Color fundus photograph. 45° FOV. 2212 by 1659 pixels.
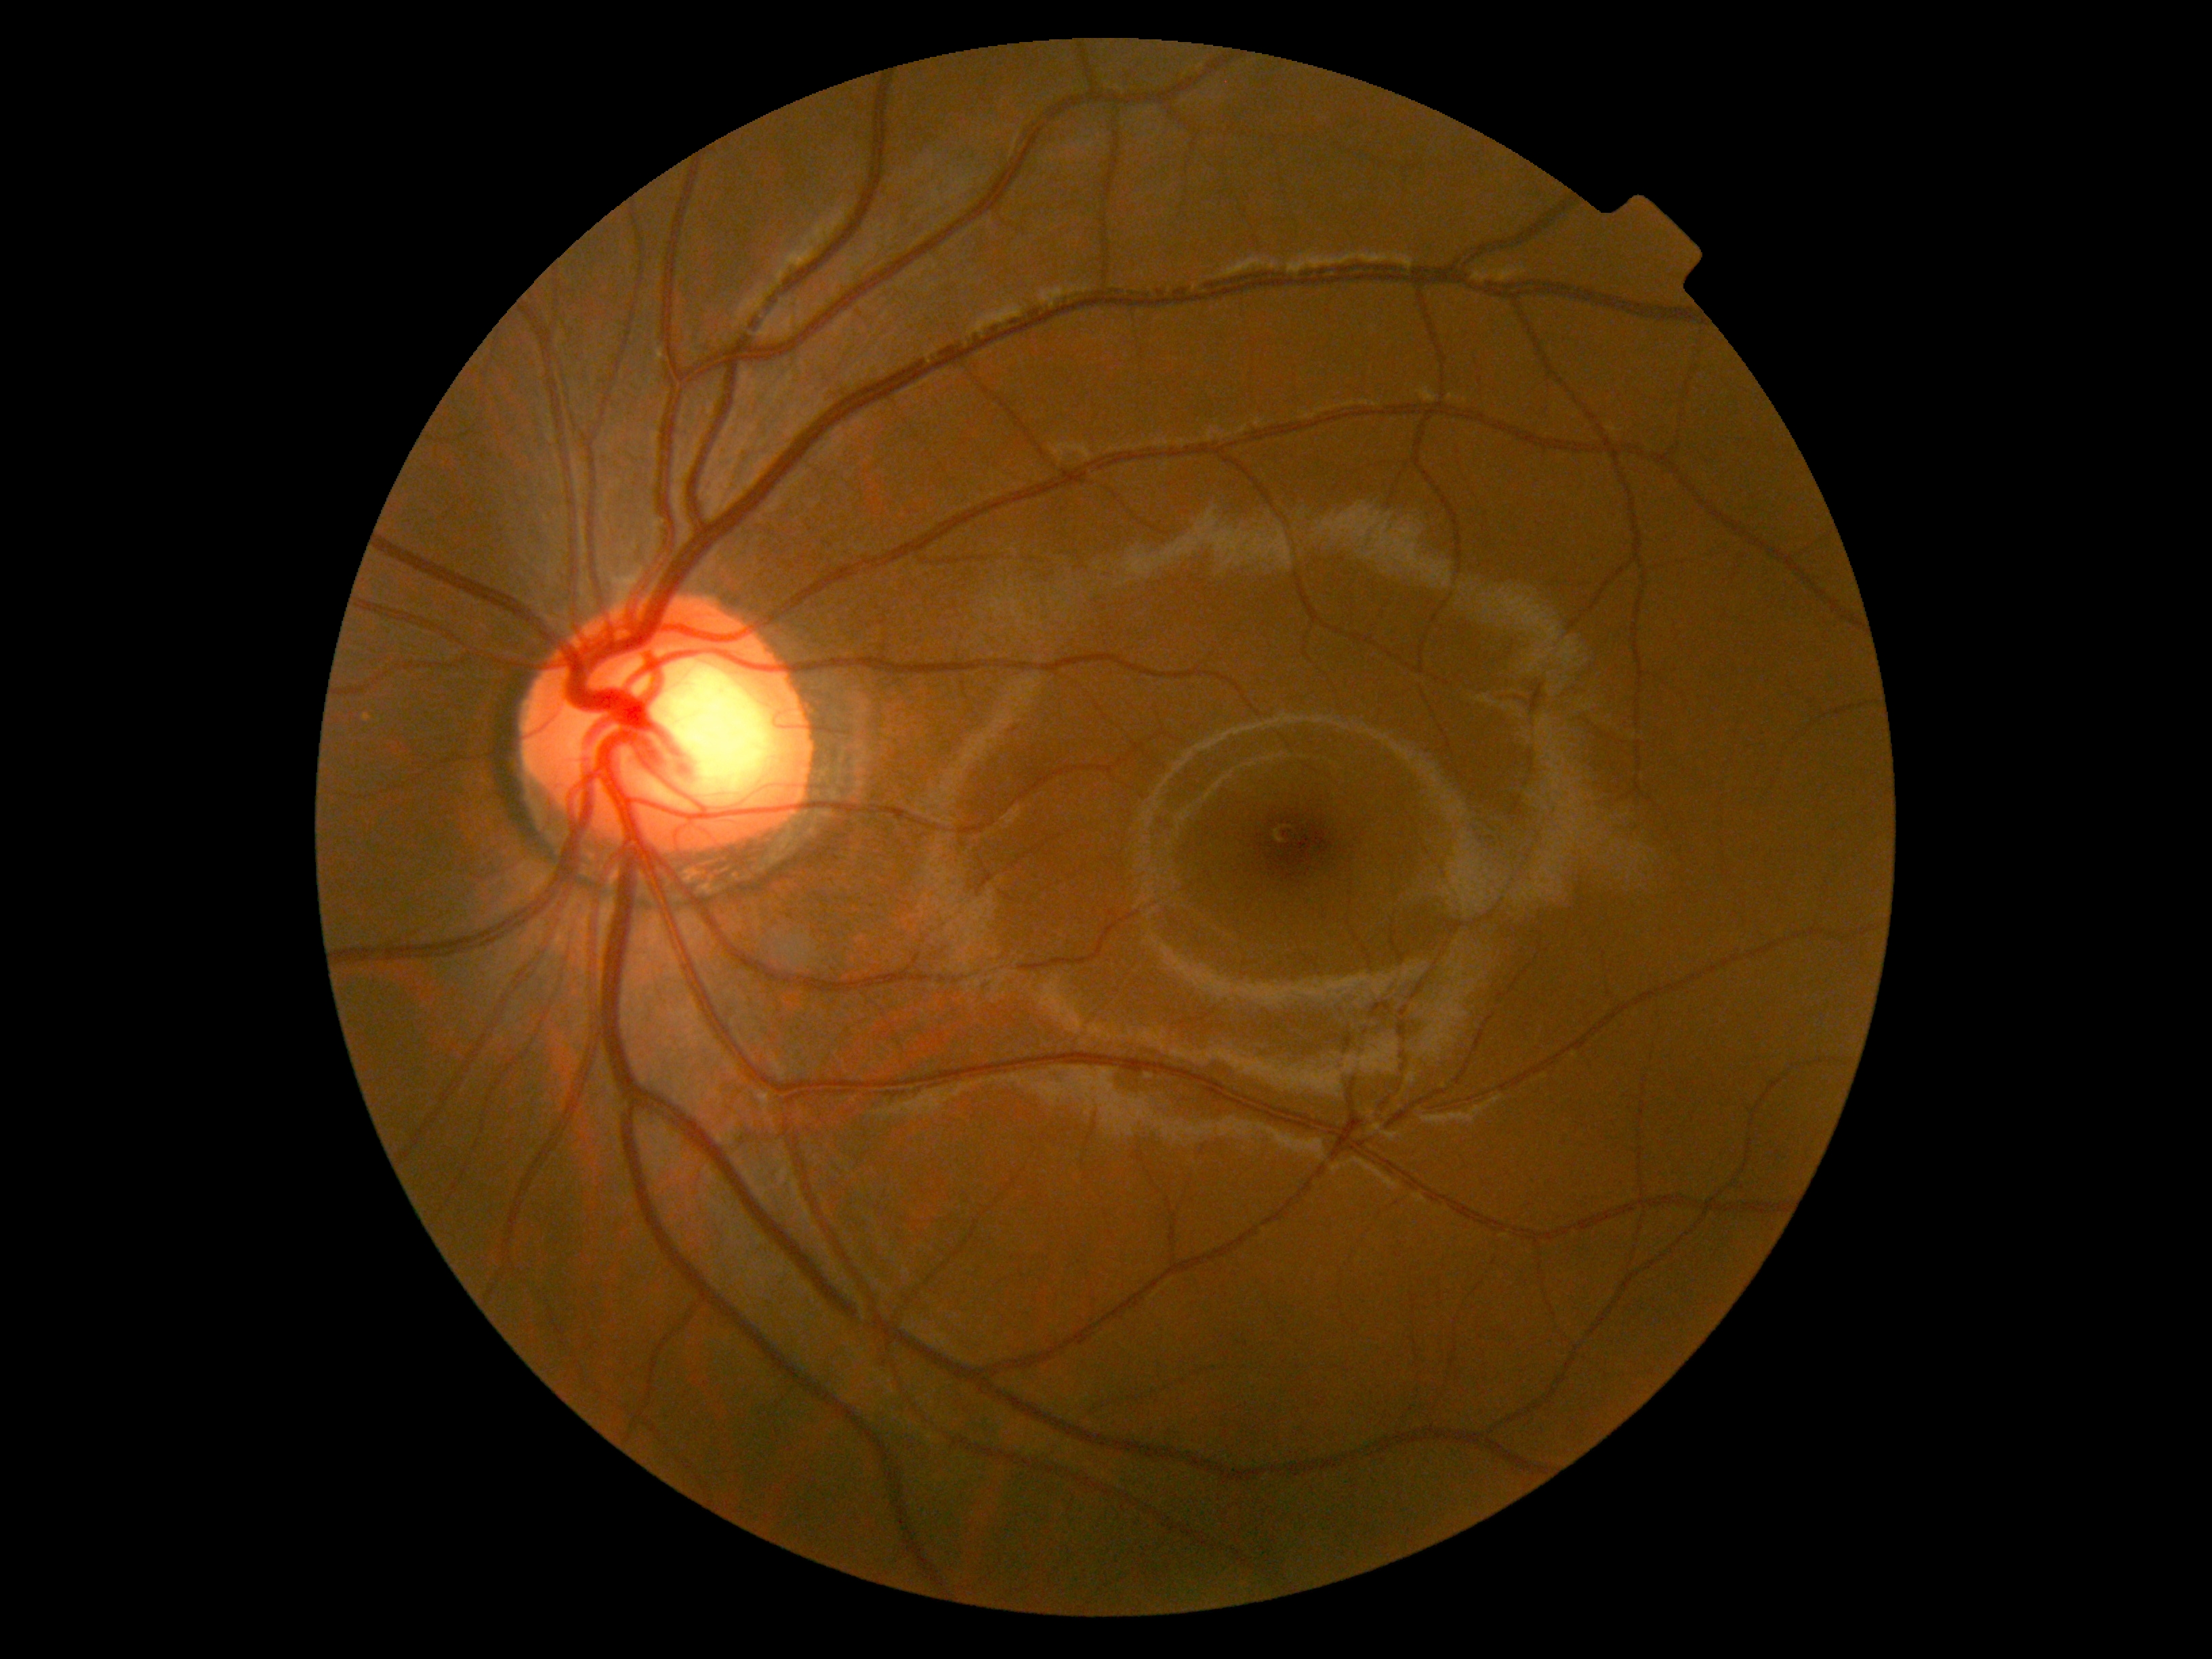

diabetic retinopathy (DR)@0/4.